Modified Davis classification: 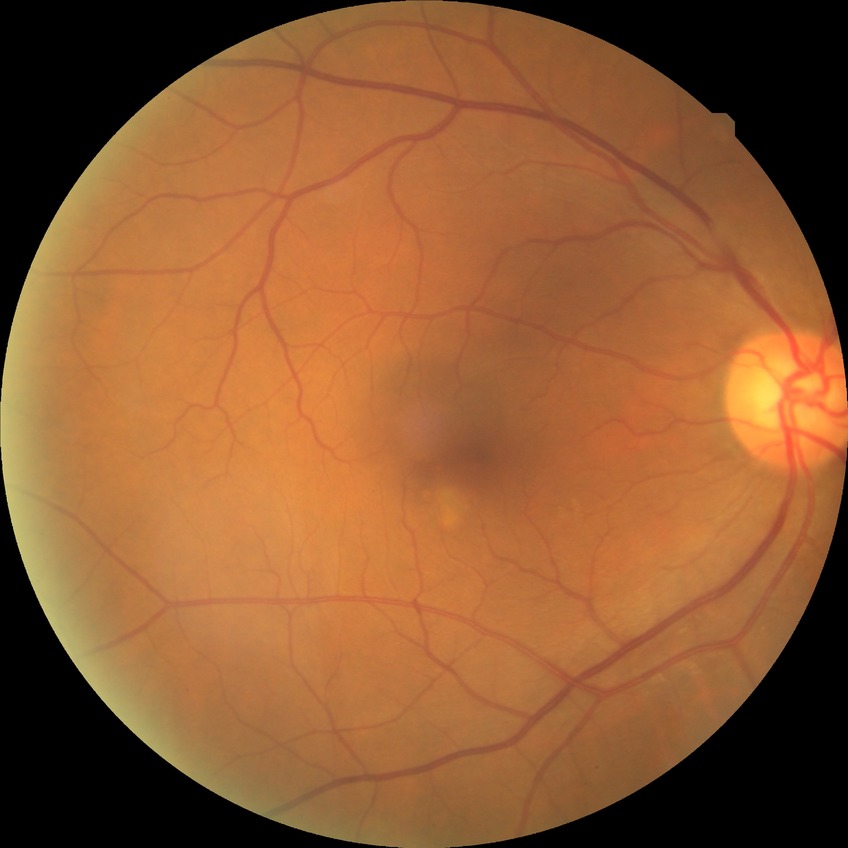 Diabetic retinopathy (DR): no diabetic retinopathy (NDR).